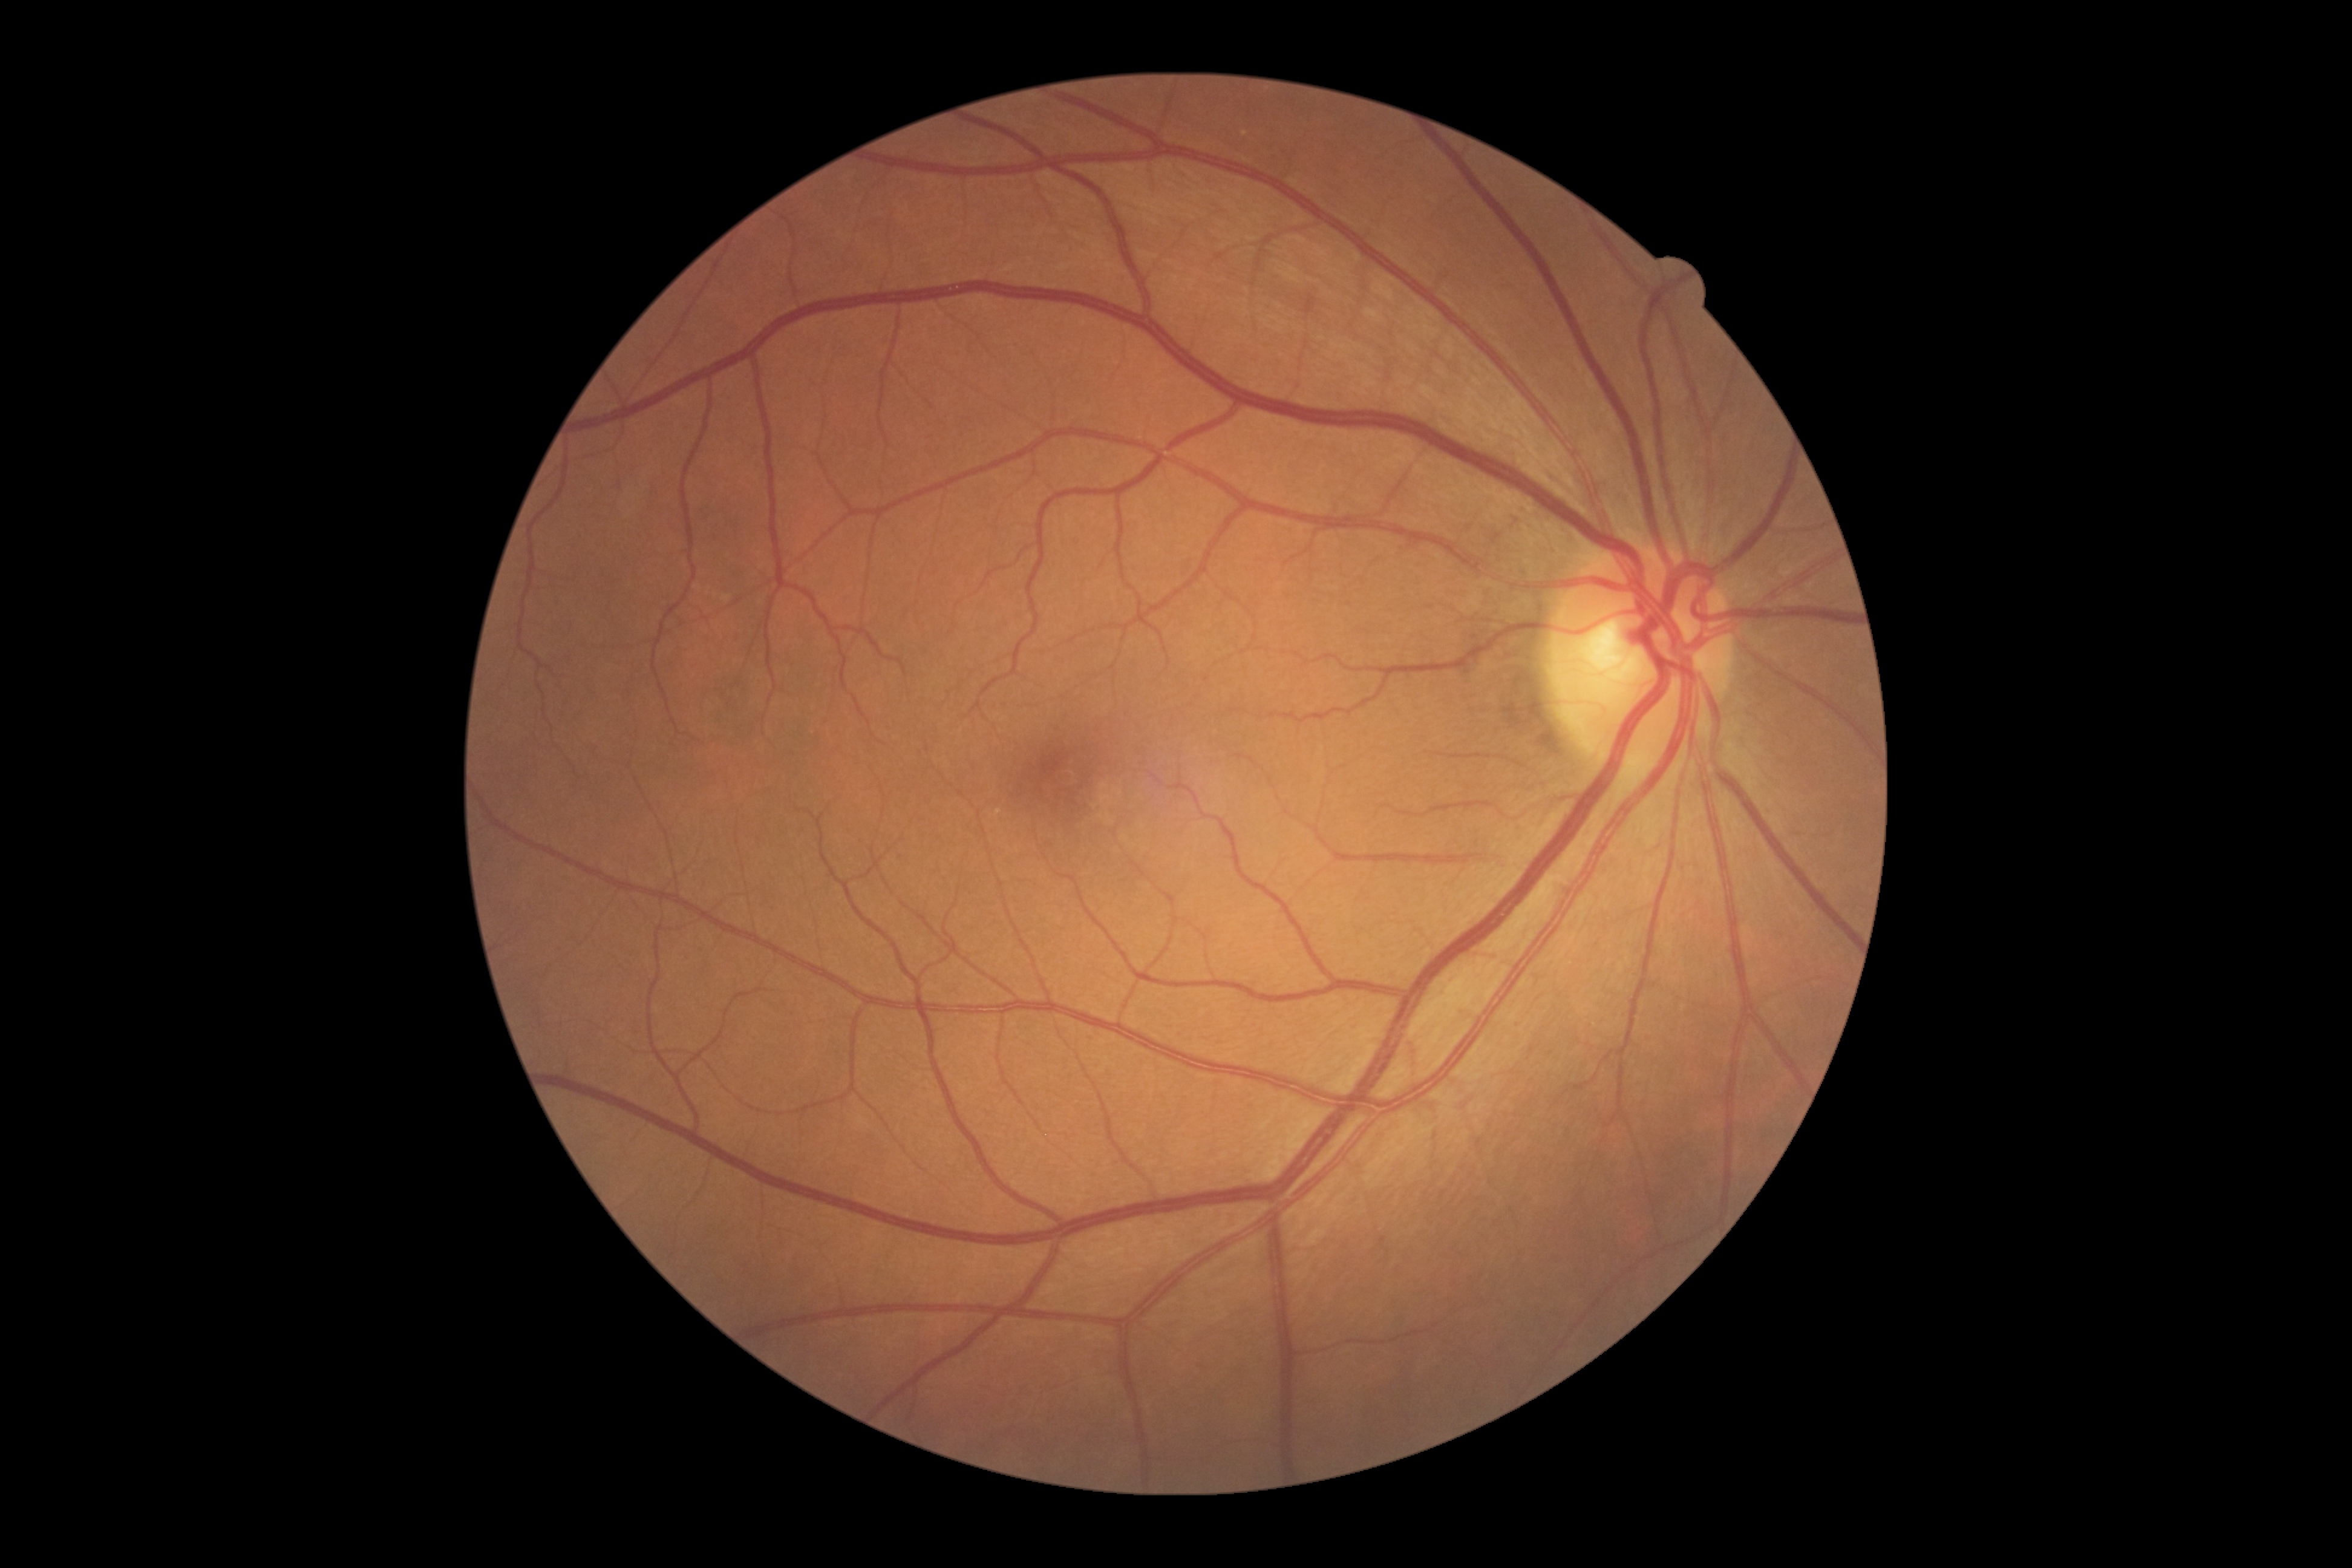
DR is grade 0 — no visible signs of diabetic retinopathy.